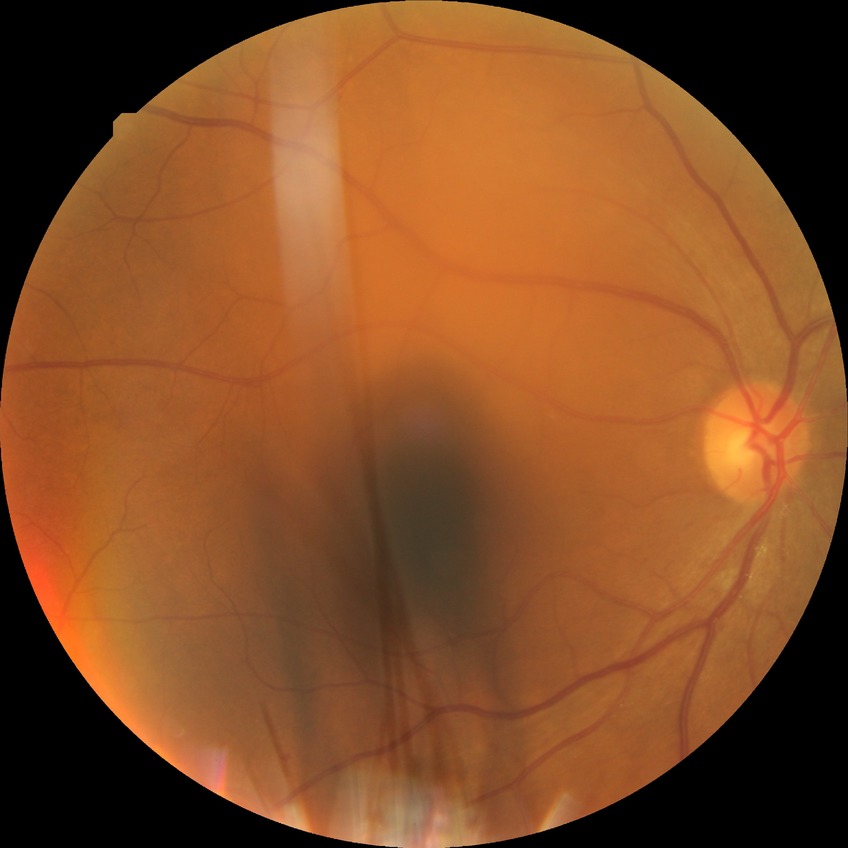   davis_grade: no diabetic retinopathy (NDR)